Image size 2352x1568 — 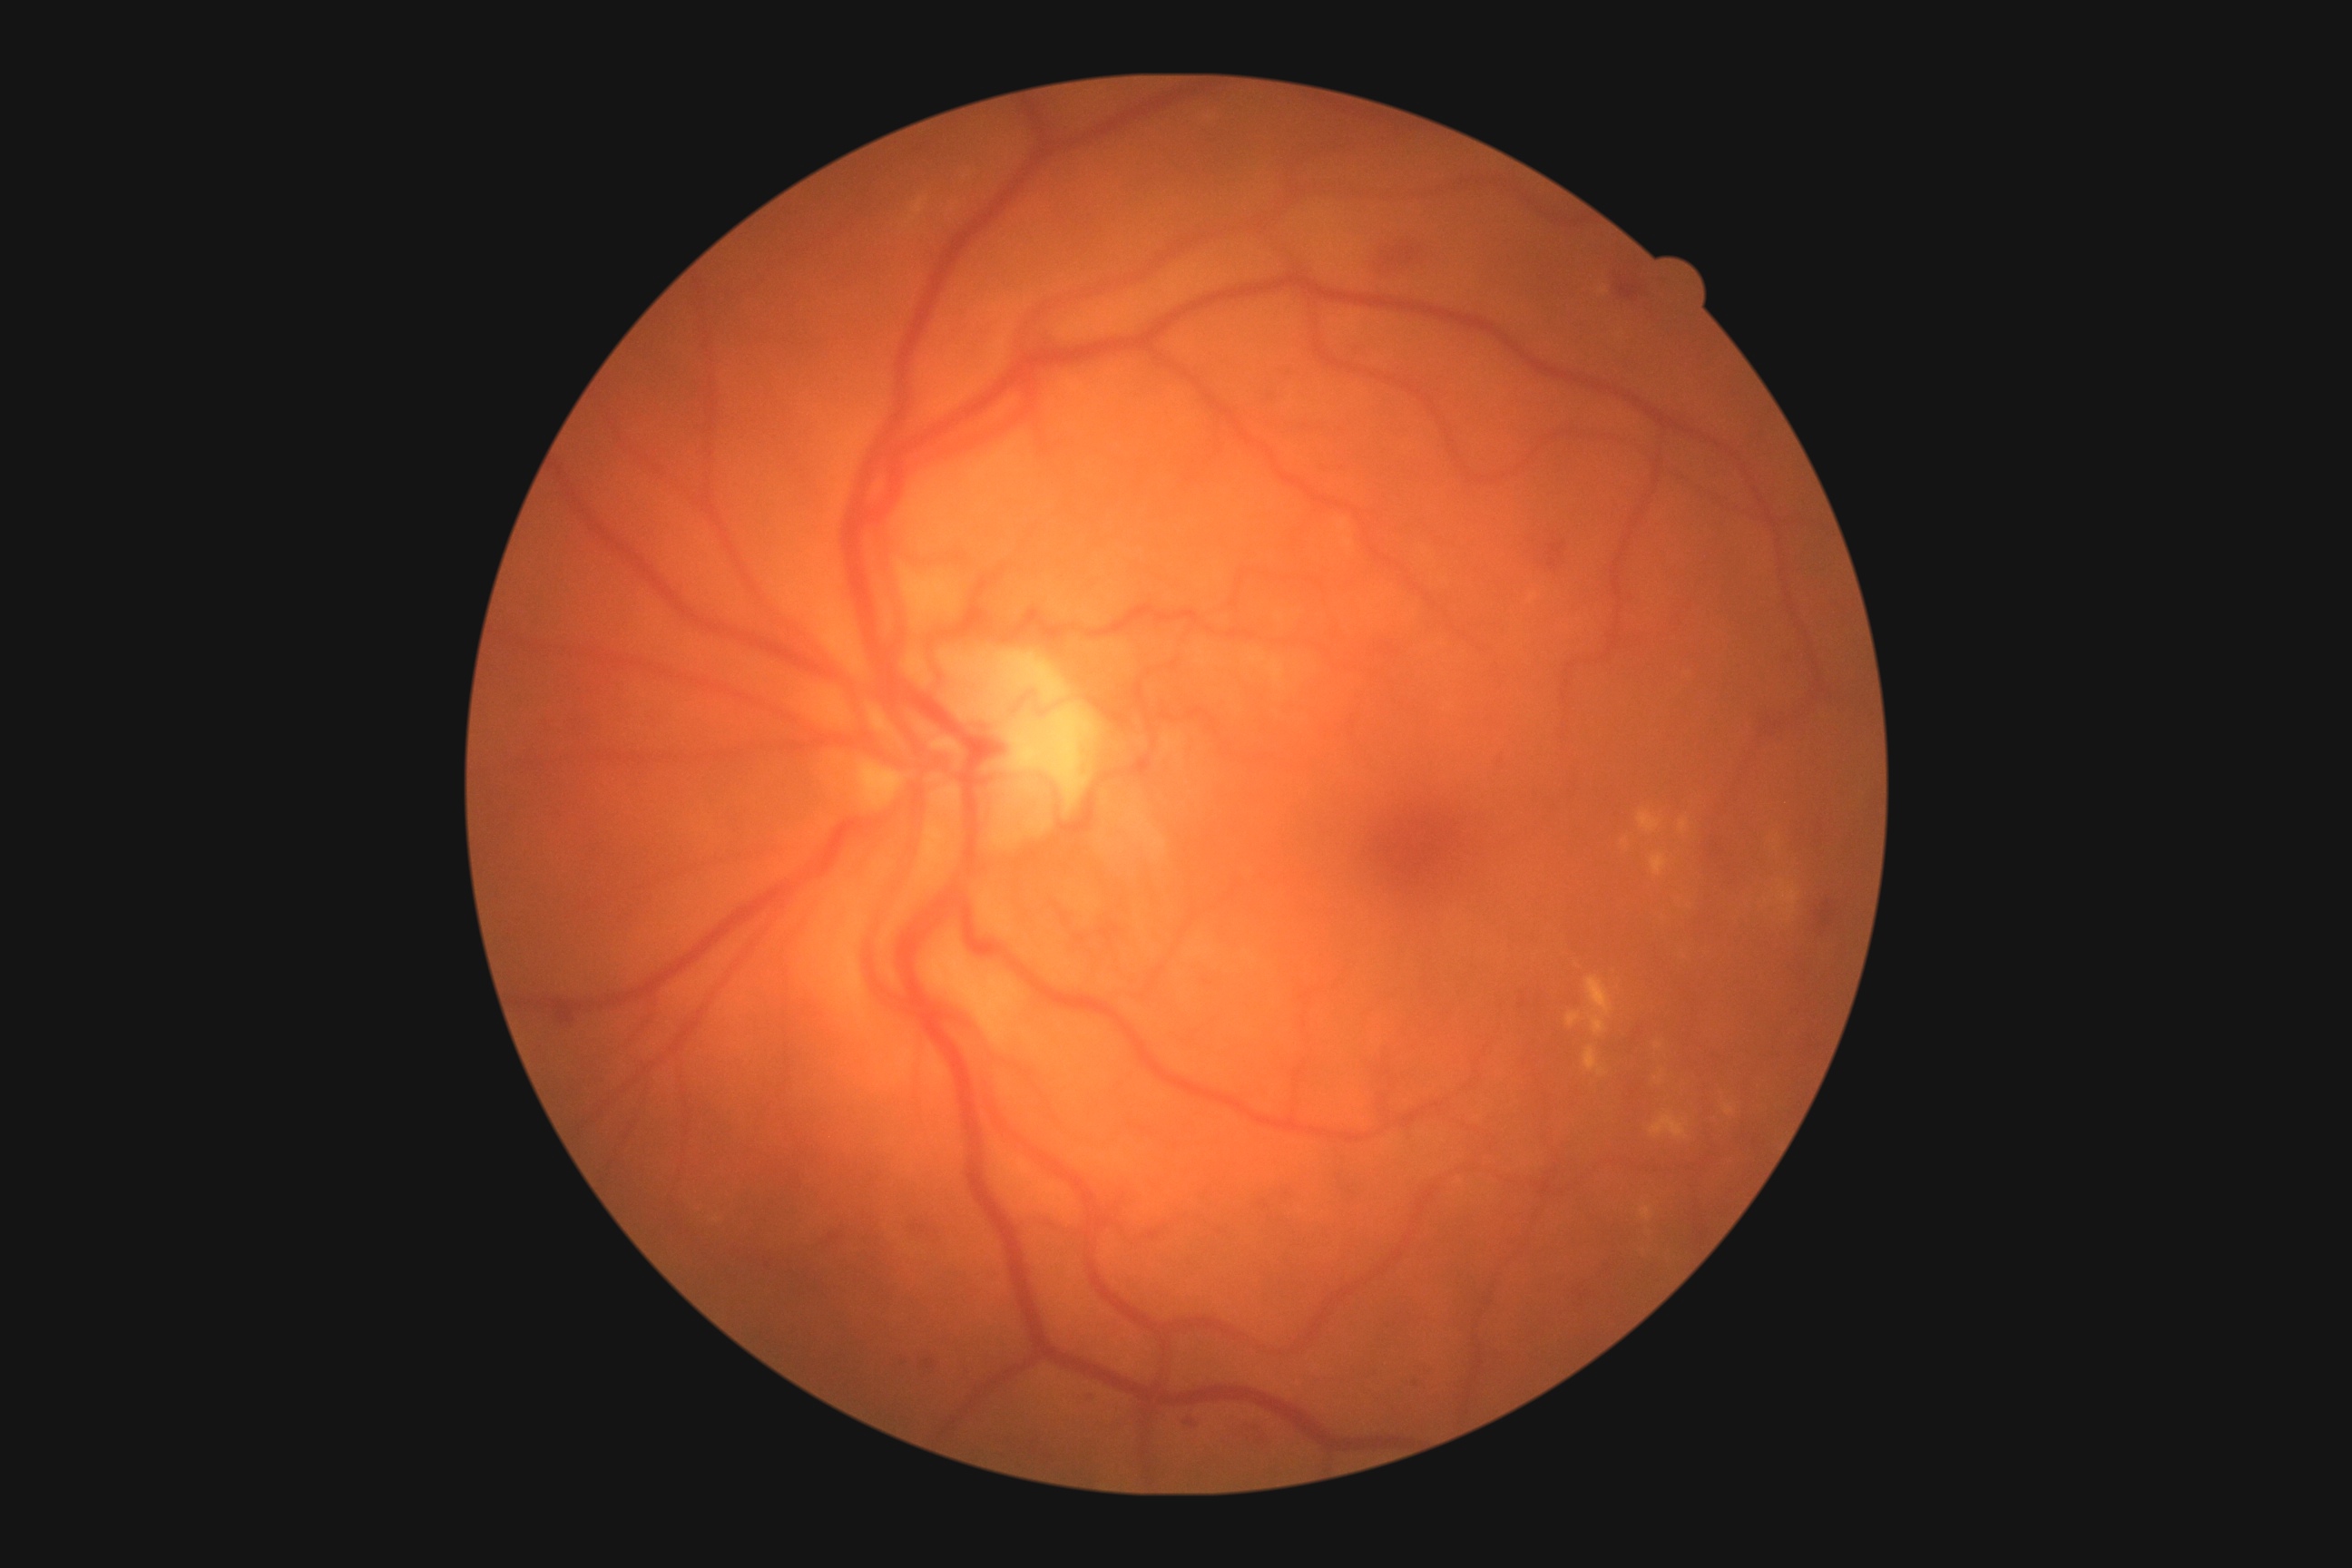 Findings:
• diabetic retinopathy grade — 2